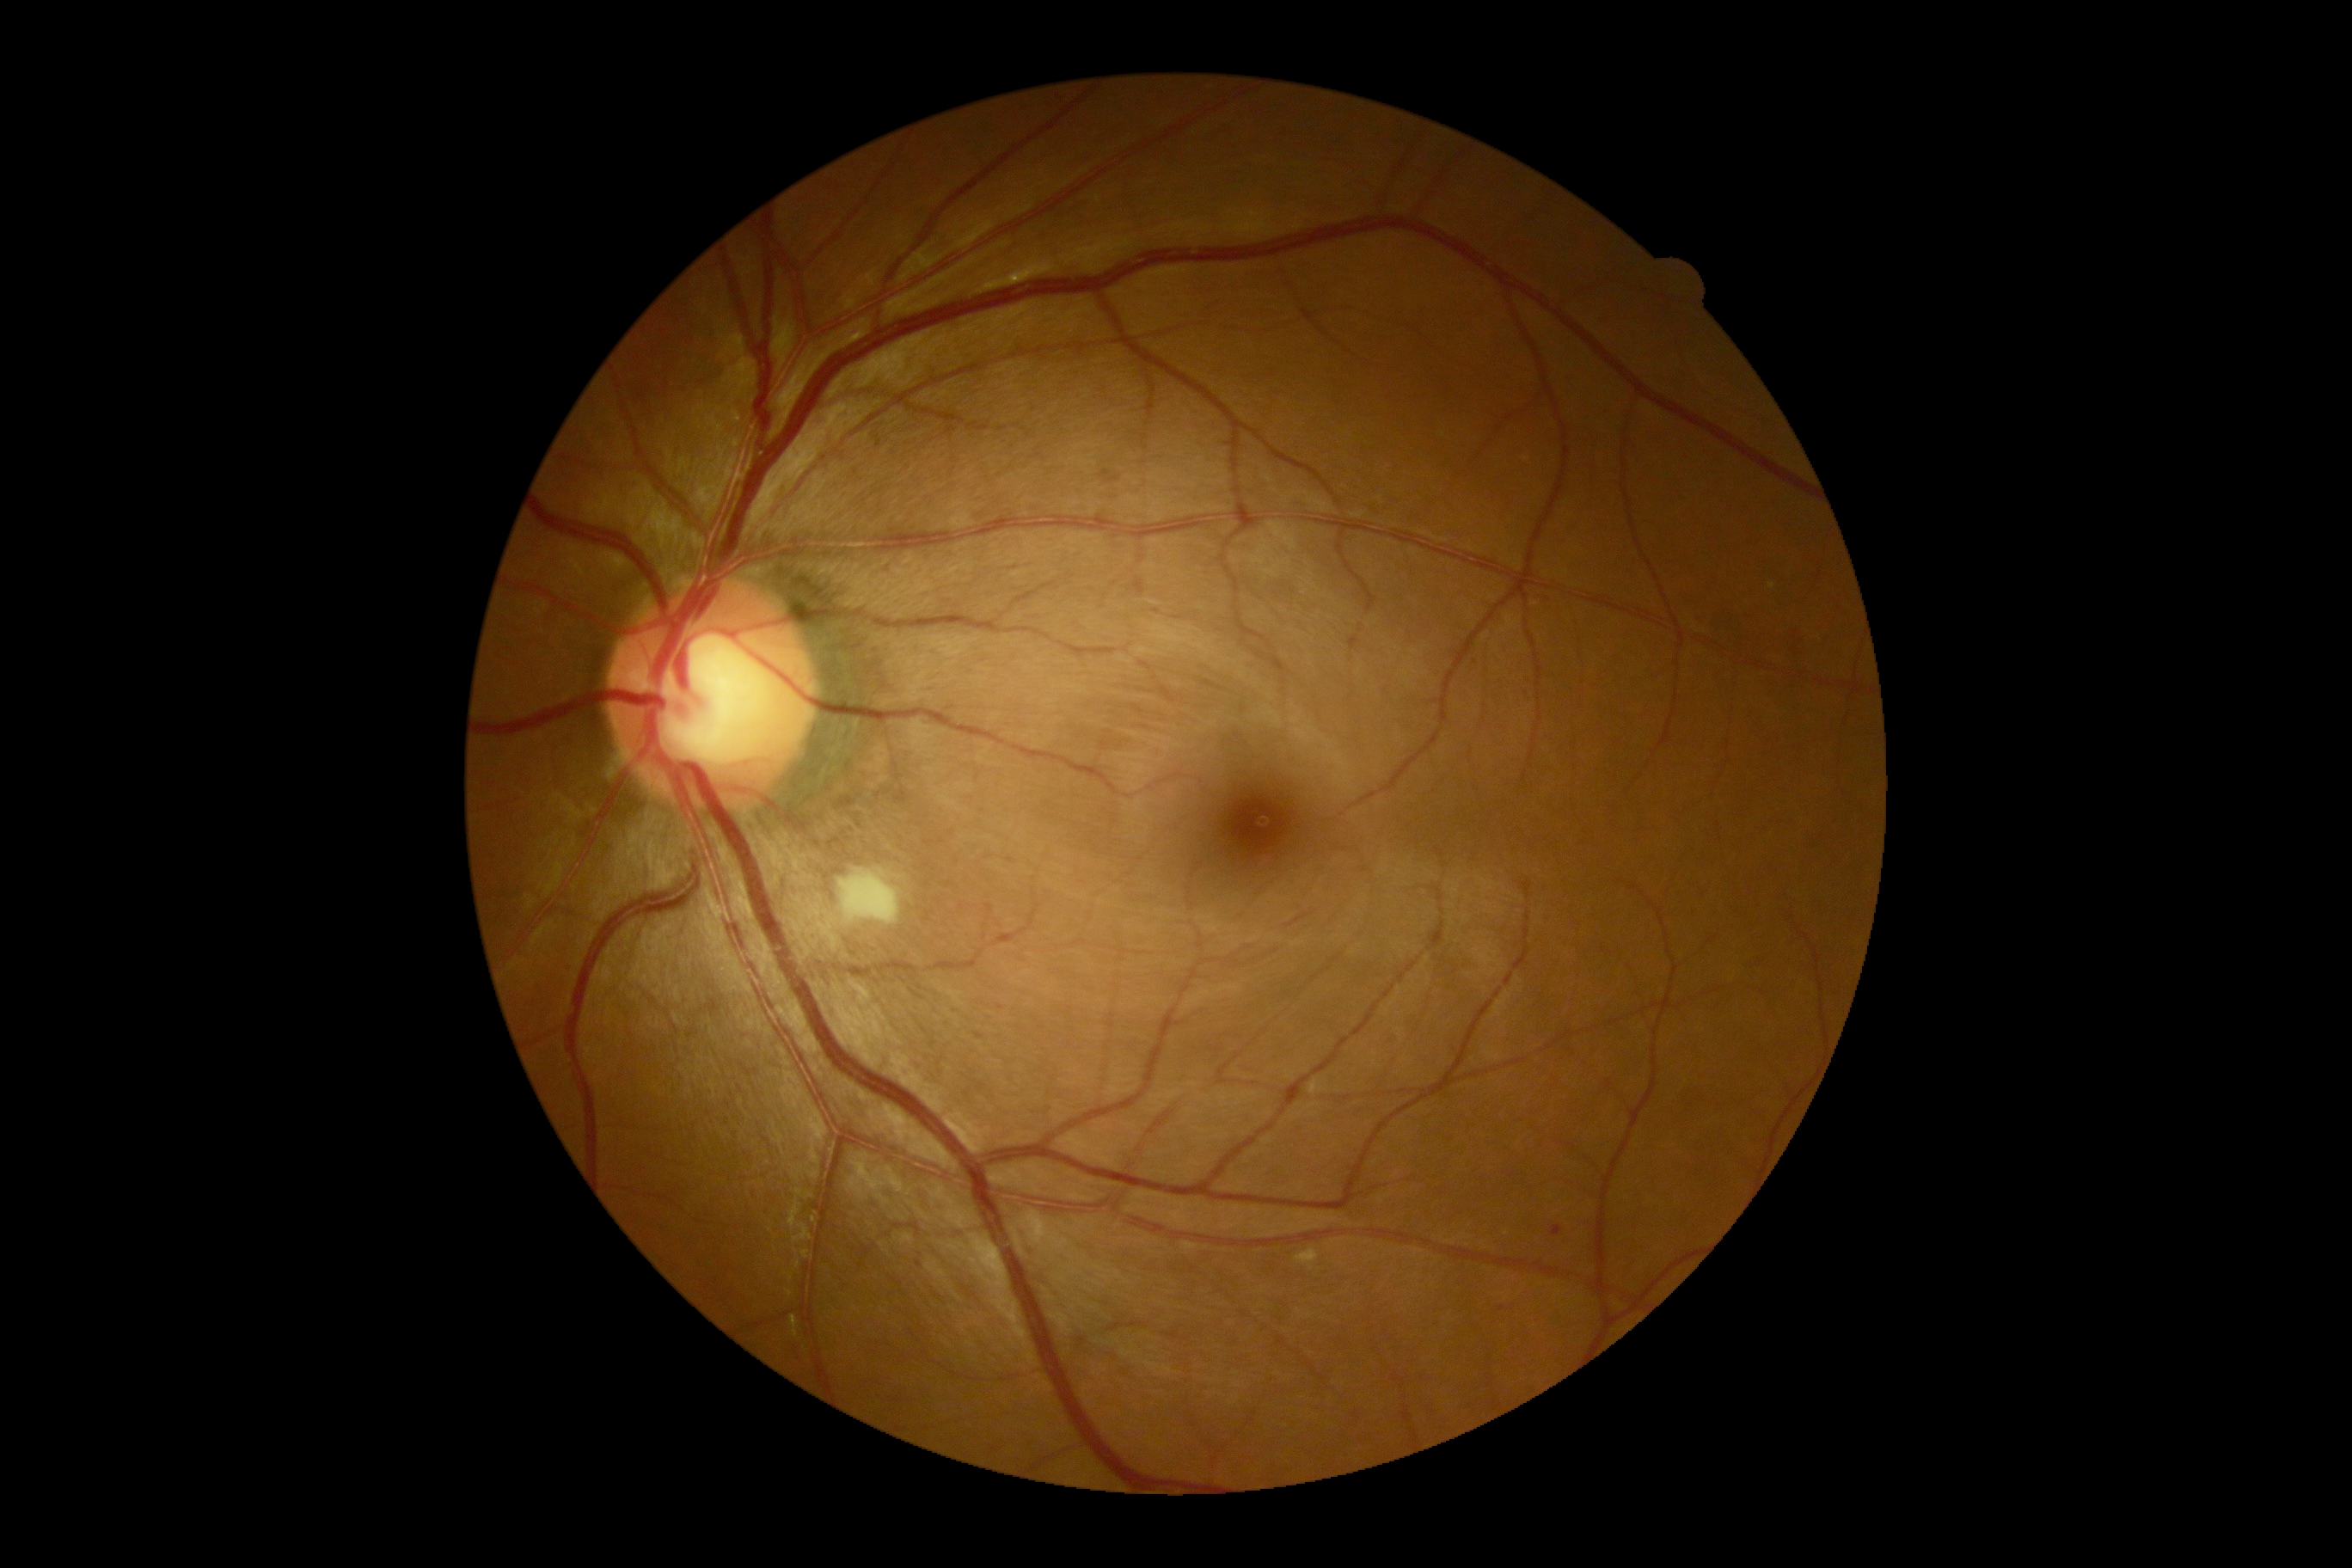 The retinopathy is classified as non-proliferative diabetic retinopathy. Diabetic retinopathy (DR) is moderate non-proliferative diabetic retinopathy (grade 2).